Pediatric retinal photograph (wide-field): 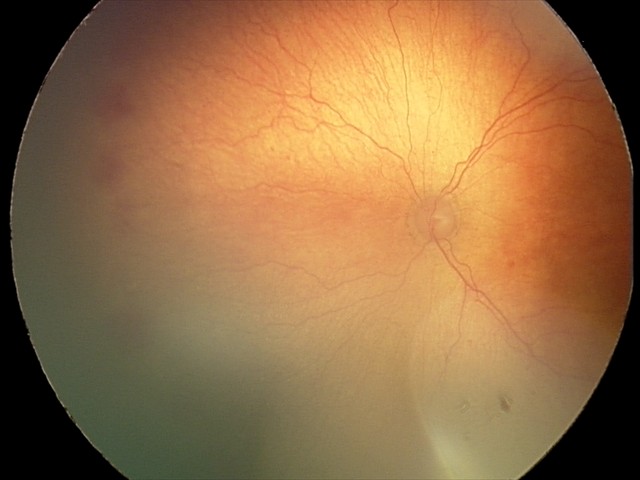 From an examination with diagnosis of aggressive ROP (A-ROP).